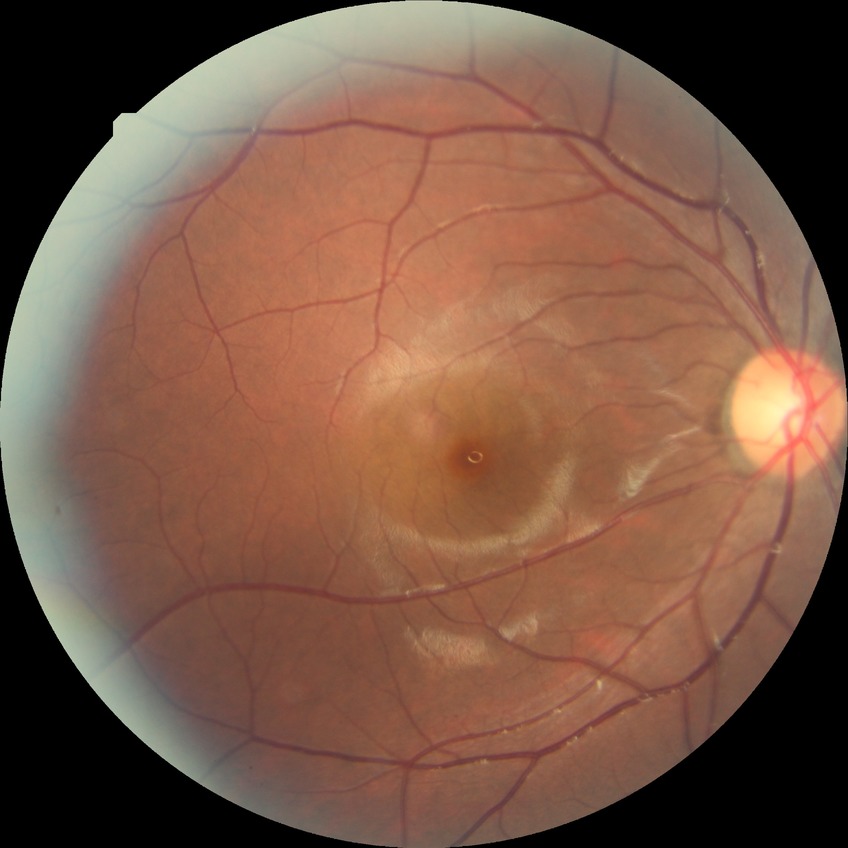 diabetic retinopathy (DR) = no diabetic retinopathy (NDR).